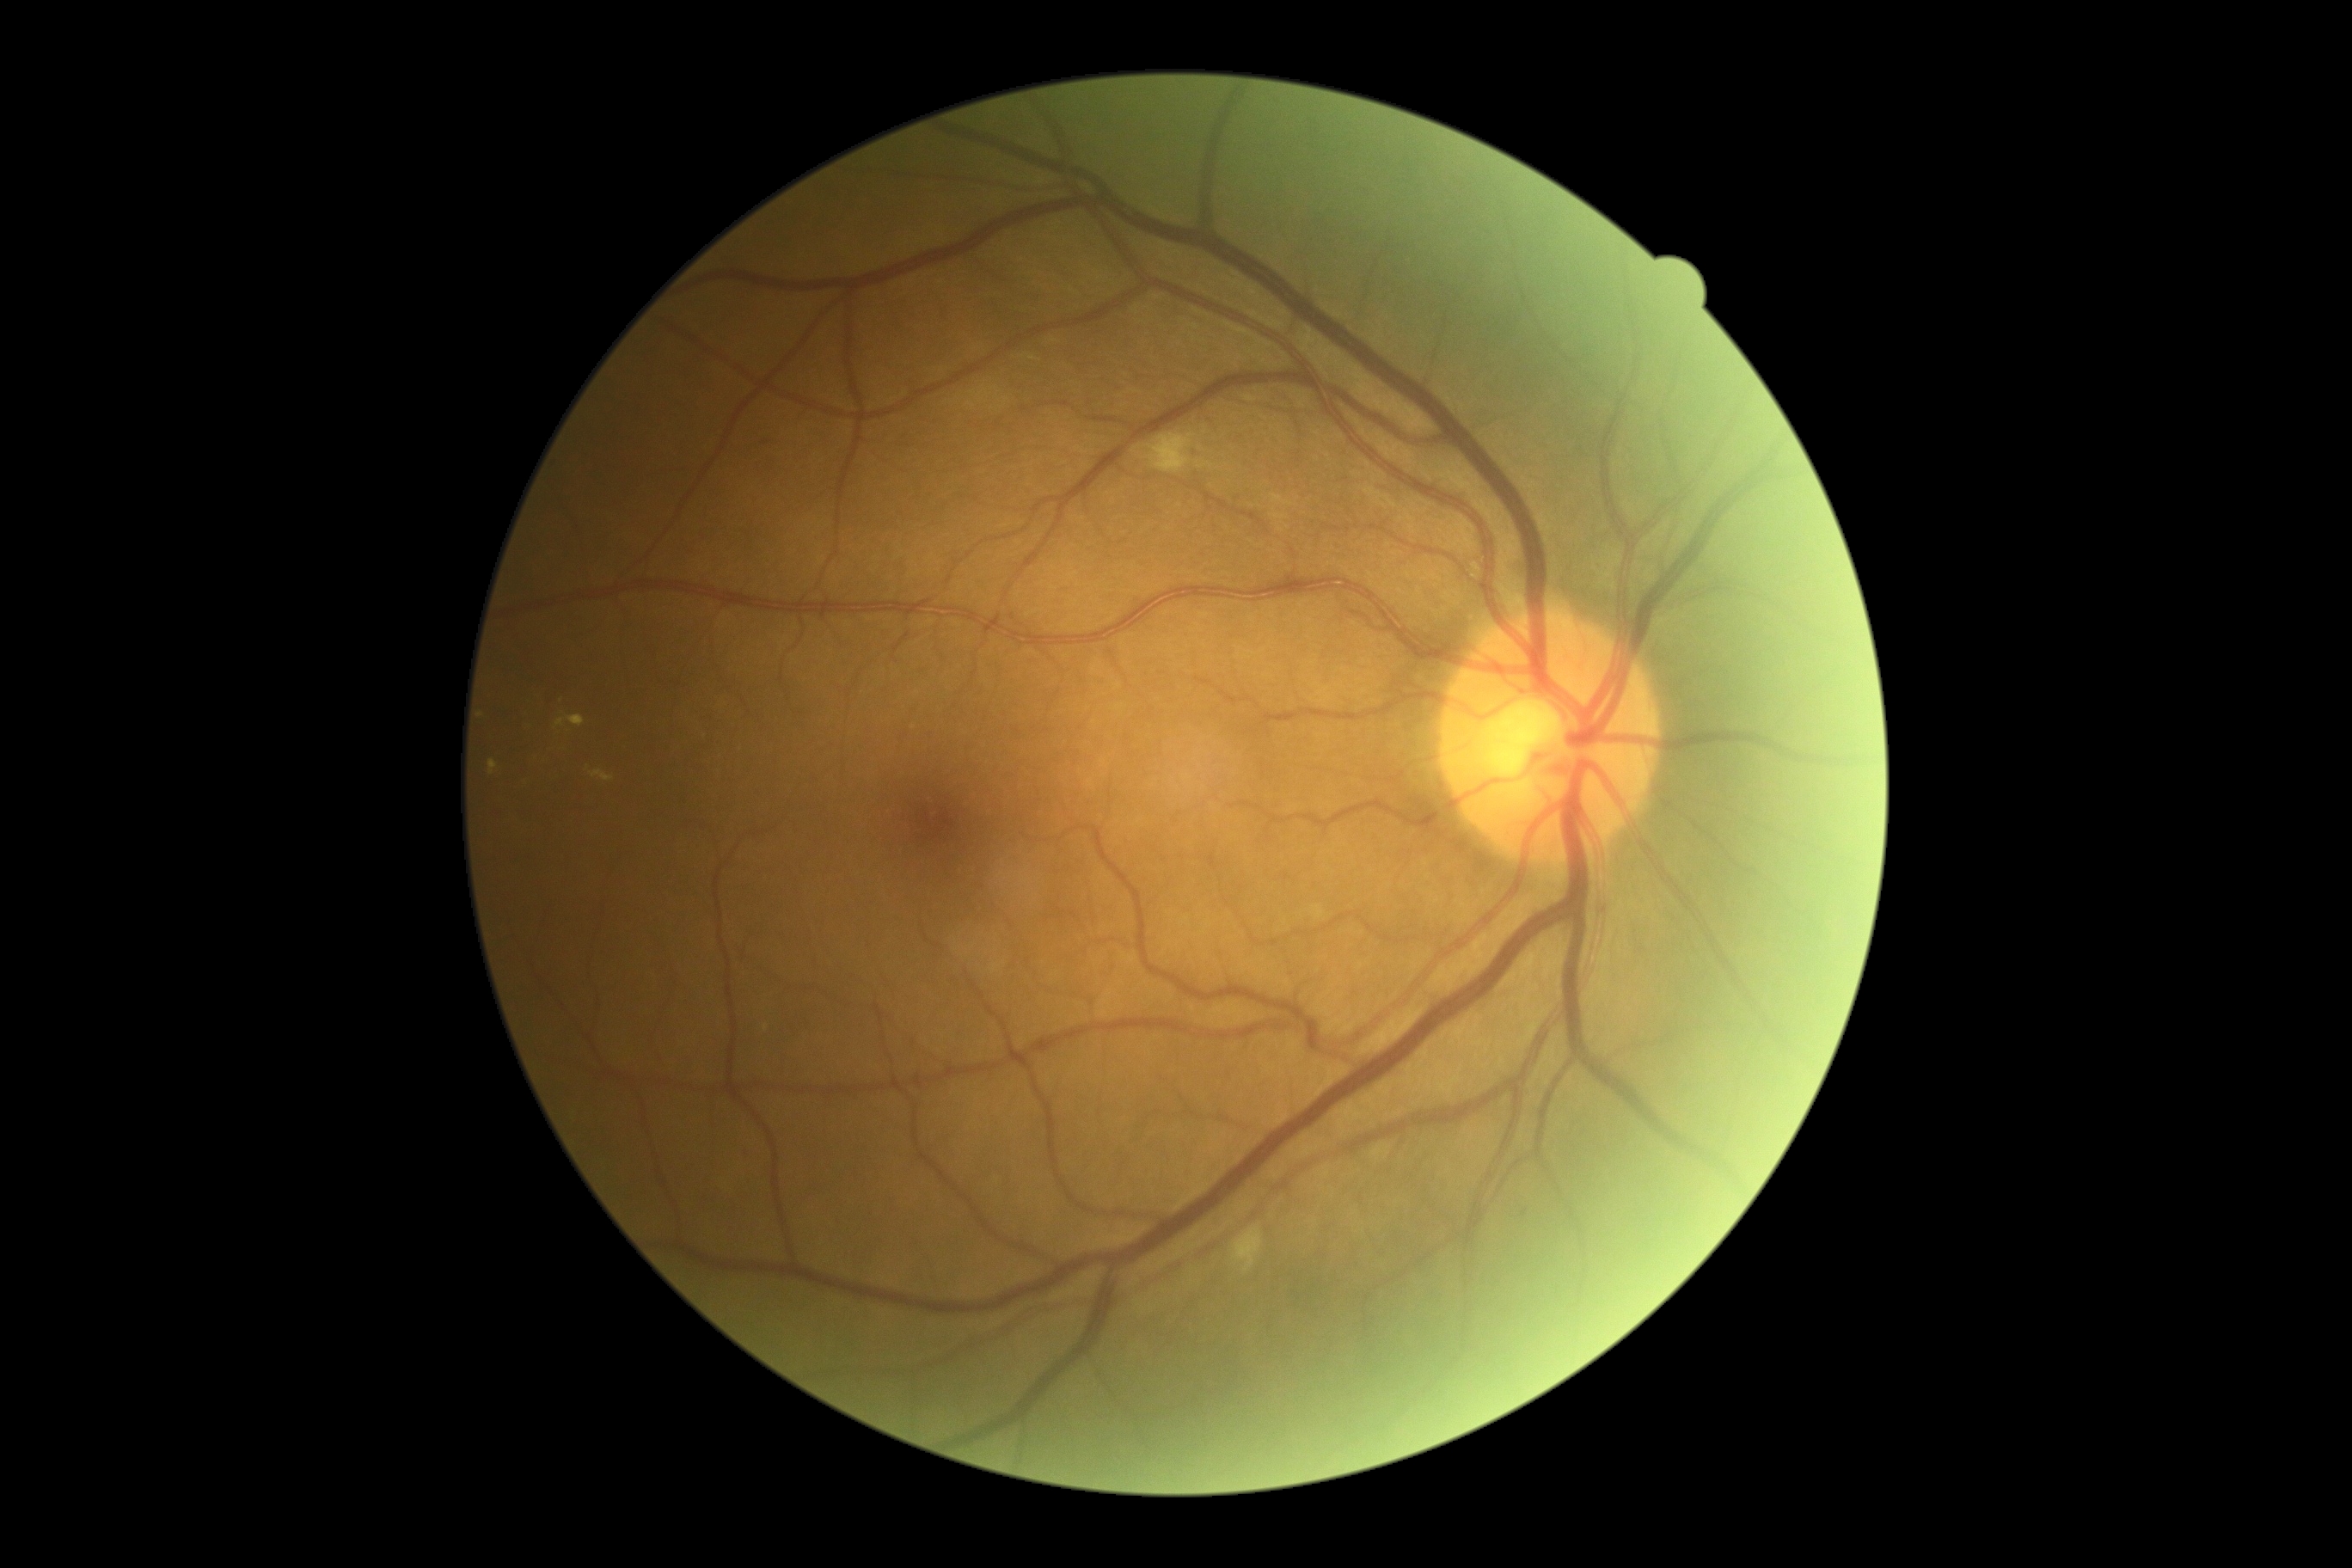
dr_grade: 2
lesions:
  he: []
  ex:
    - Rect(591, 771, 615, 783)
    - Rect(1371, 1144, 1390, 1160)
    - Rect(1313, 907, 1325, 921)
    - Rect(489, 761, 498, 775)
    - Rect(554, 716, 585, 730)
  se:
    - Rect(1232, 1227, 1263, 1275)
    - Rect(1146, 434, 1196, 474)
  ma:
    - Rect(745, 1151, 752, 1160)
  ma_small:
    - (1525, 1213)